Wide-field fundus photograph from neonatal ROP screening · 1240 x 1240 pixels — 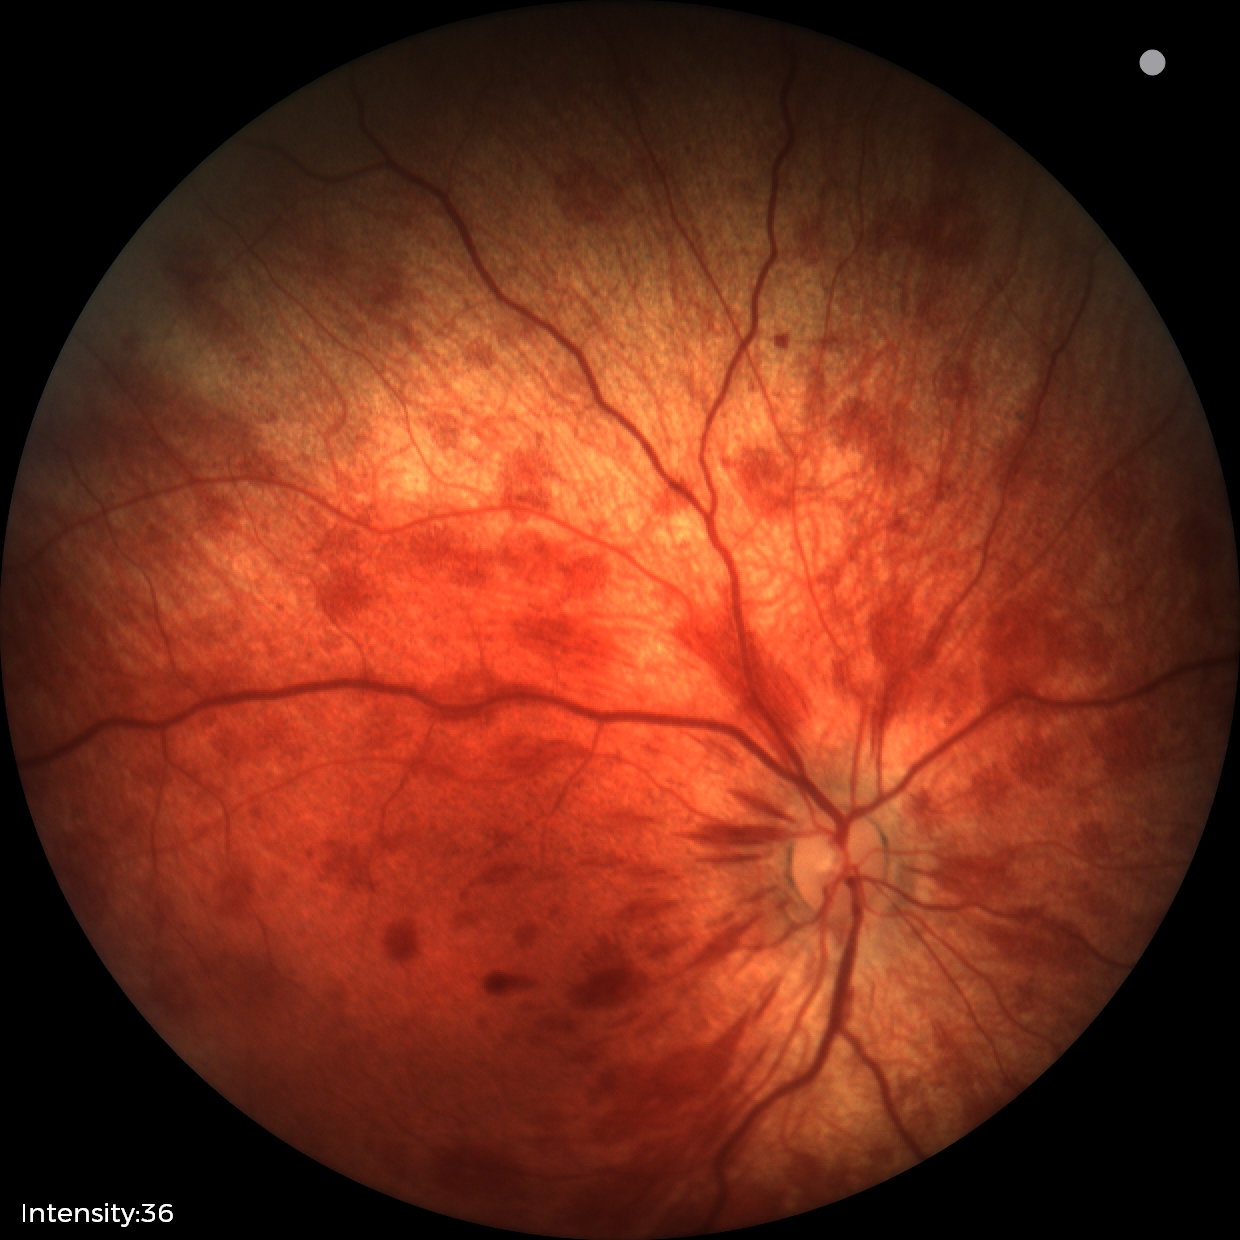 From an examination with diagnosis of retinal hemorrhages.